CFP.
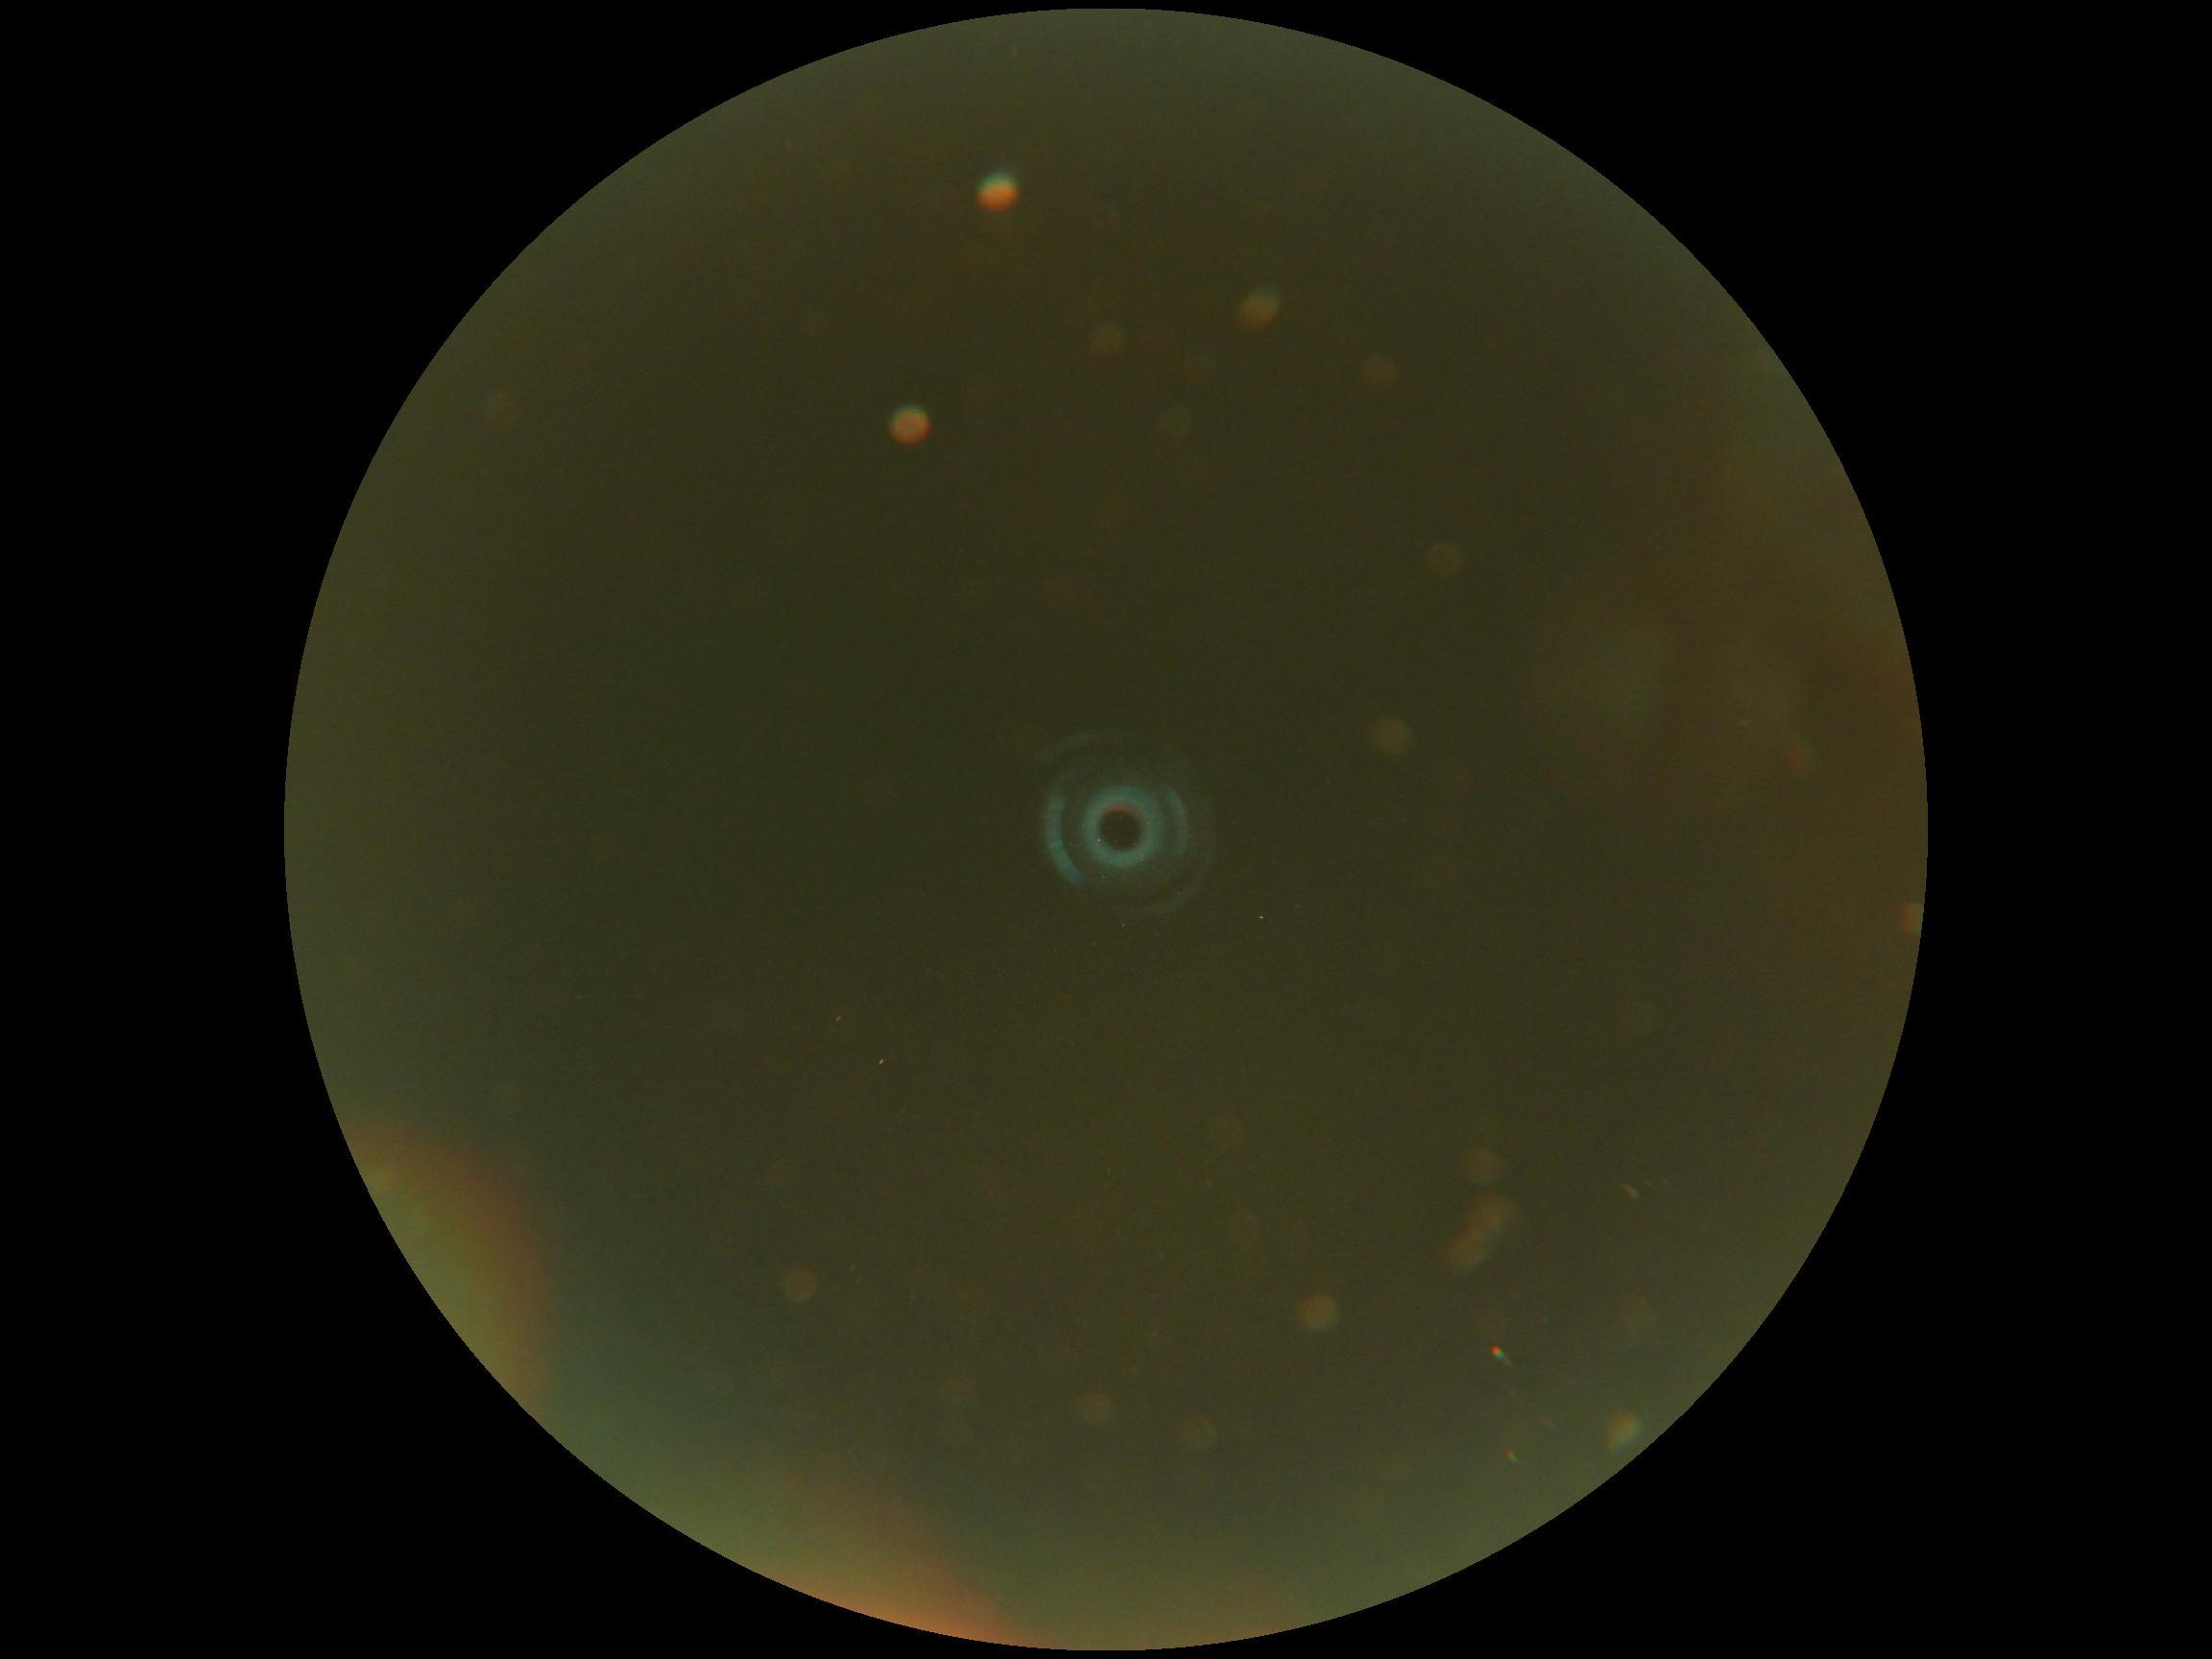

- retinopathy grade: ungradable
- image quality: too poor for DR grading